Davis DR grading.
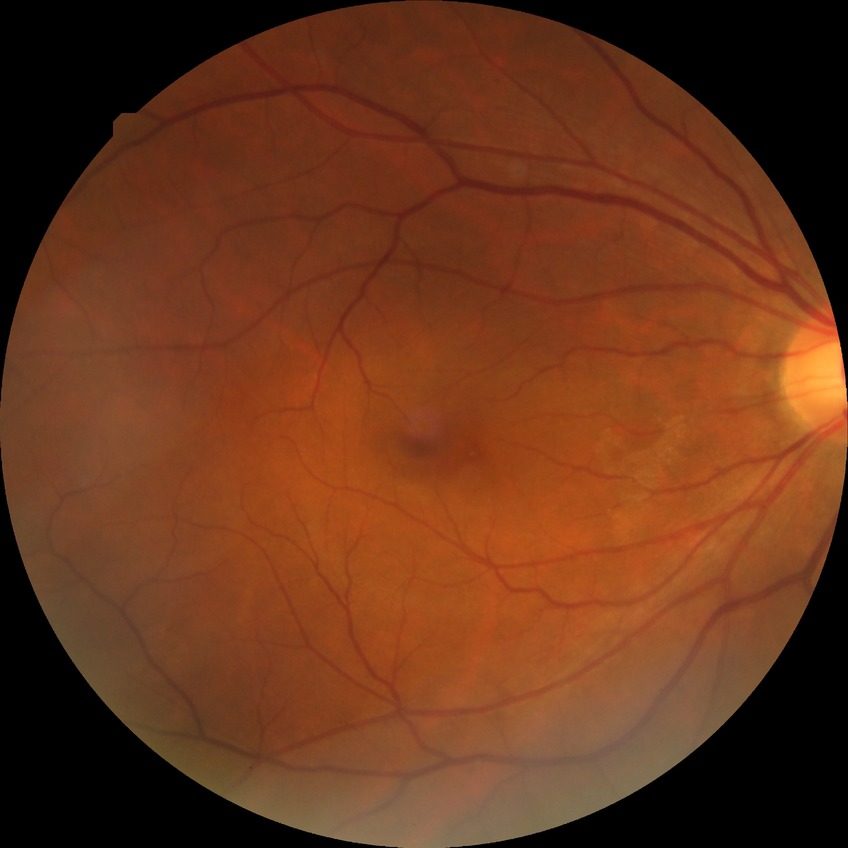
  davis_grade: NDR (no diabetic retinopathy)